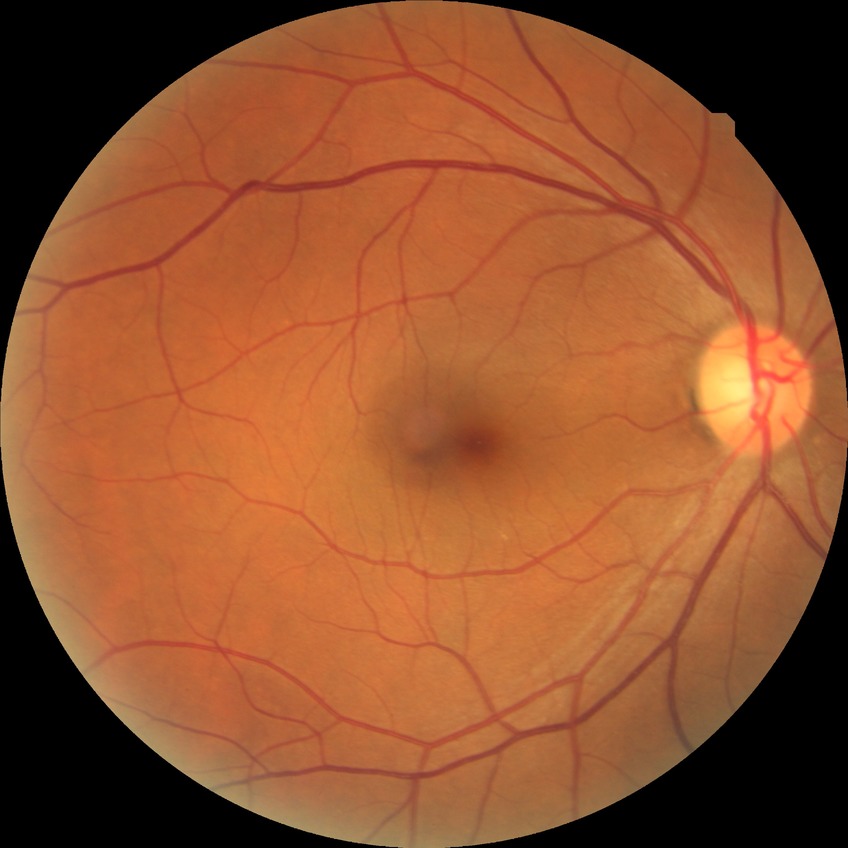

Diabetic retinopathy (DR) is no diabetic retinopathy (NDR).